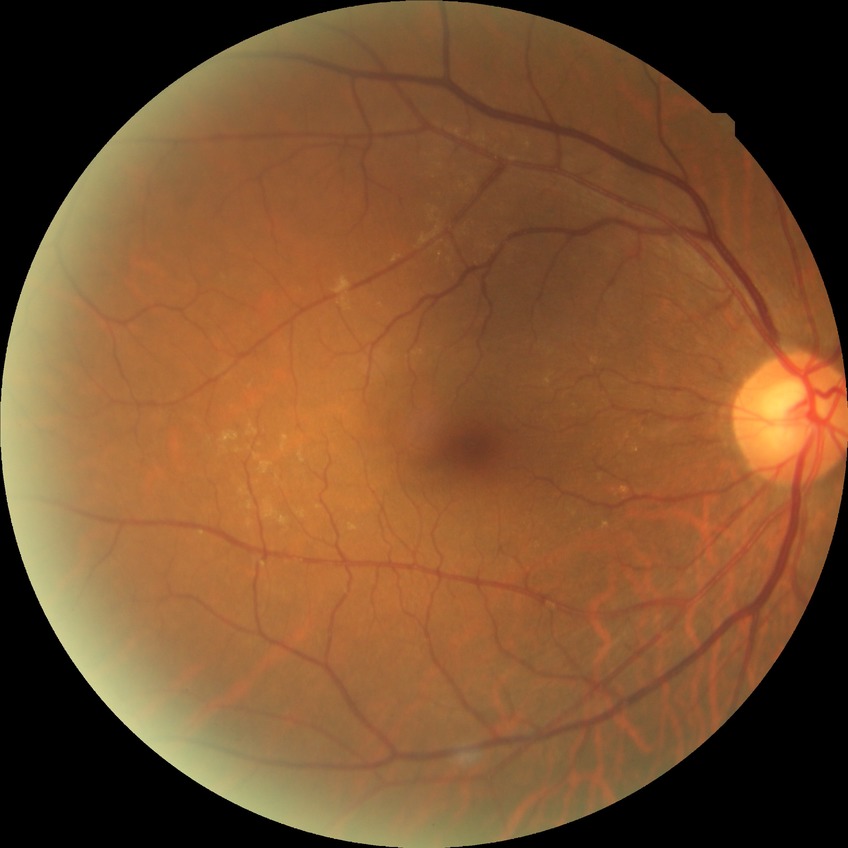

Diabetic retinopathy (DR) is no diabetic retinopathy (NDR).